Captured with the Phoenix ICON (100° field of view). Wide-field fundus photograph from neonatal ROP screening: 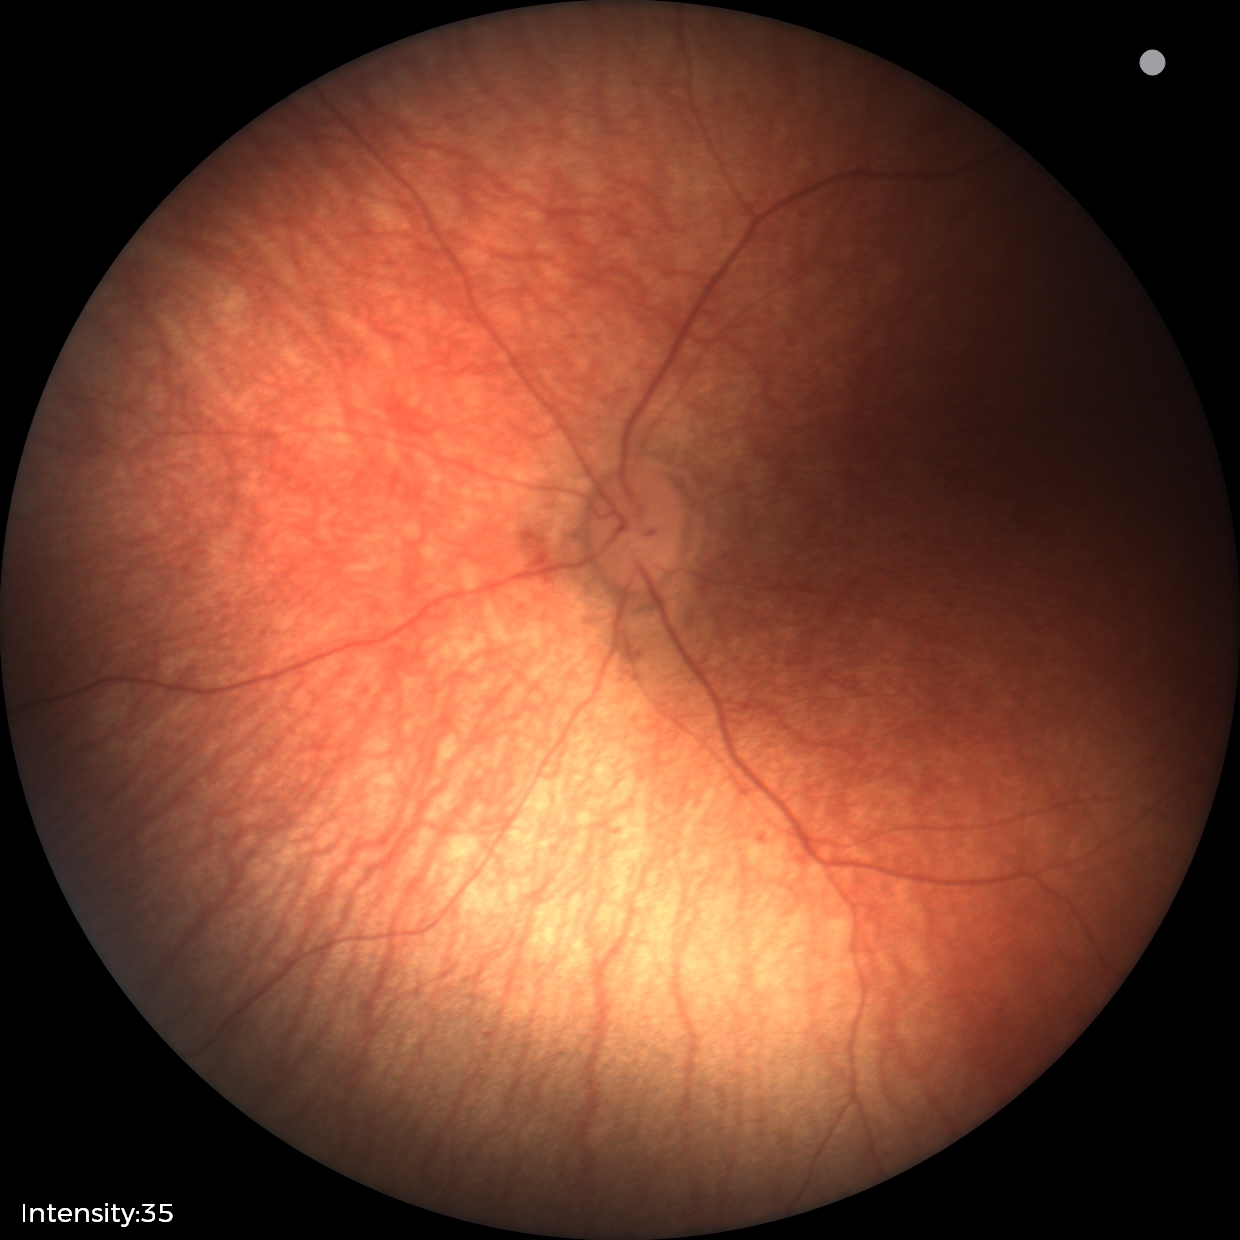

Impression: normal retinal appearance.